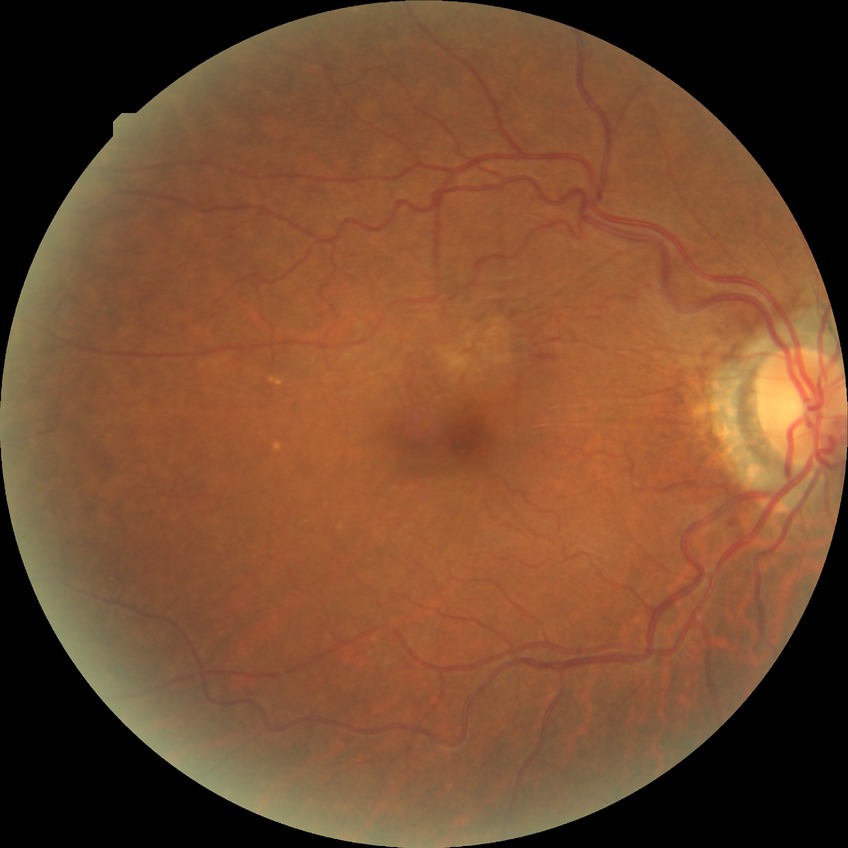 * Davis grade — NDR
* DR impression — no DR findings